2212 x 1672 pixels. Fundus photo.
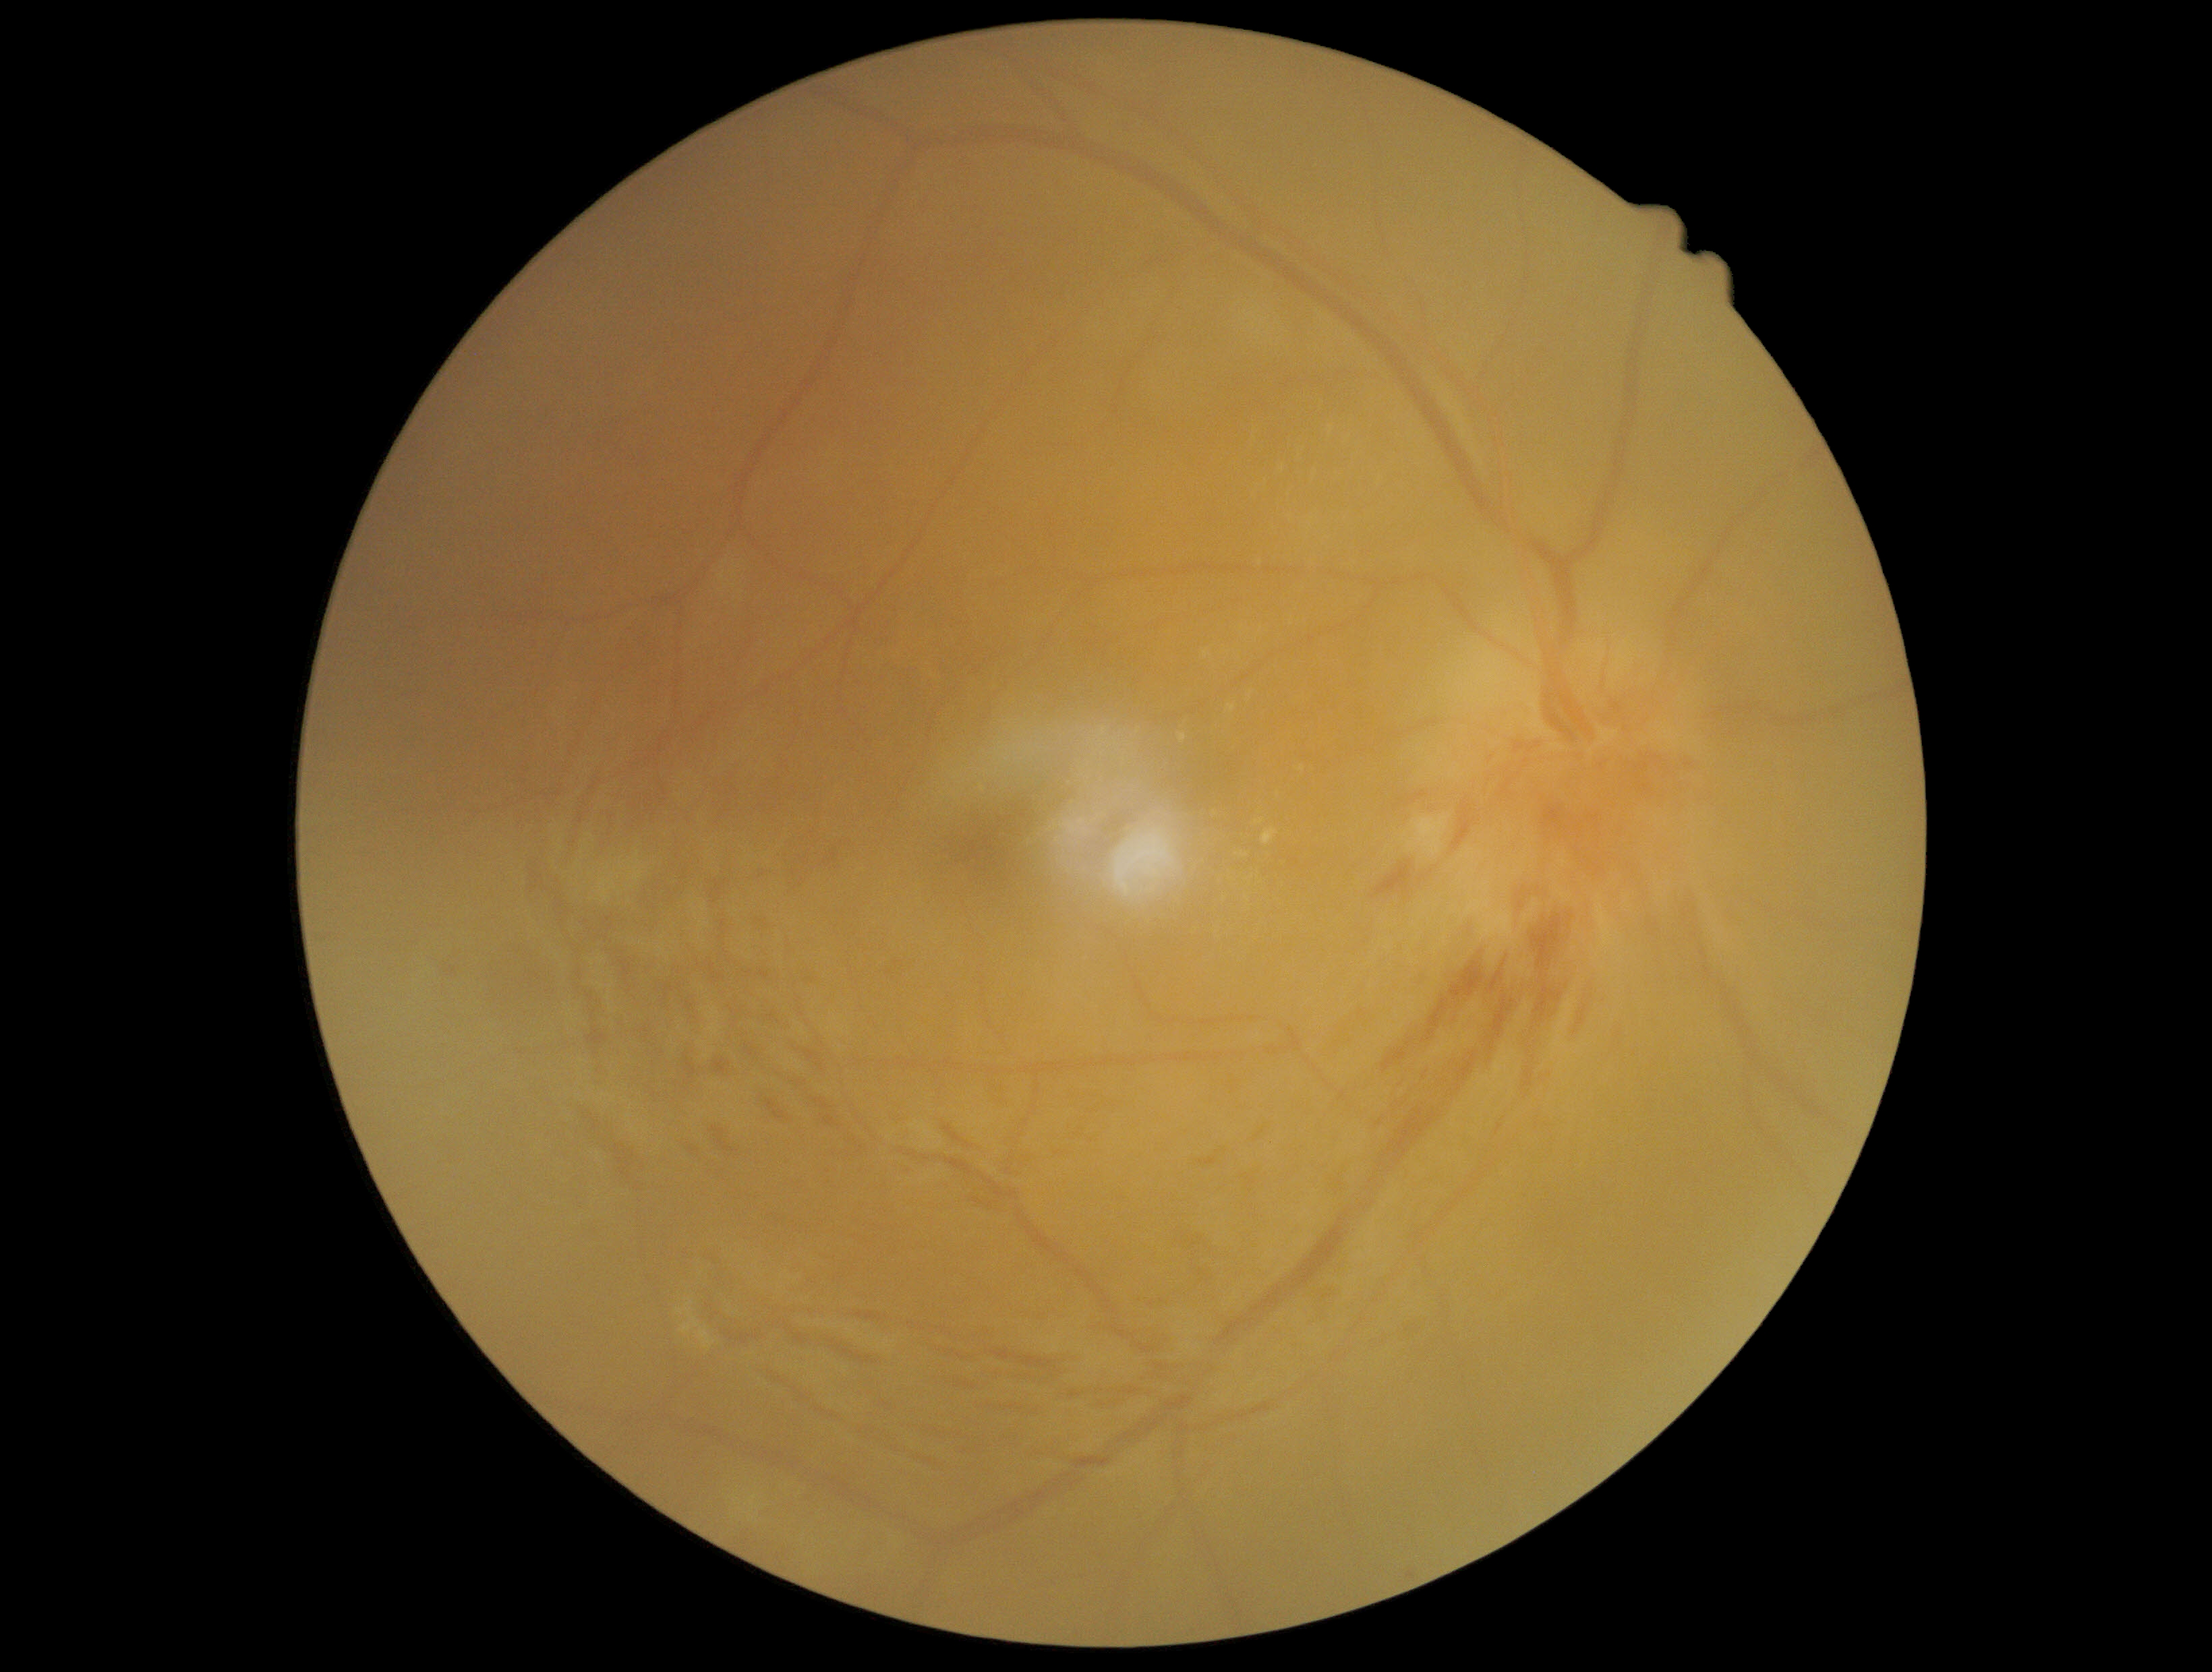
Diabetic retinopathy (DR): 2.